Image size 2089x1764: 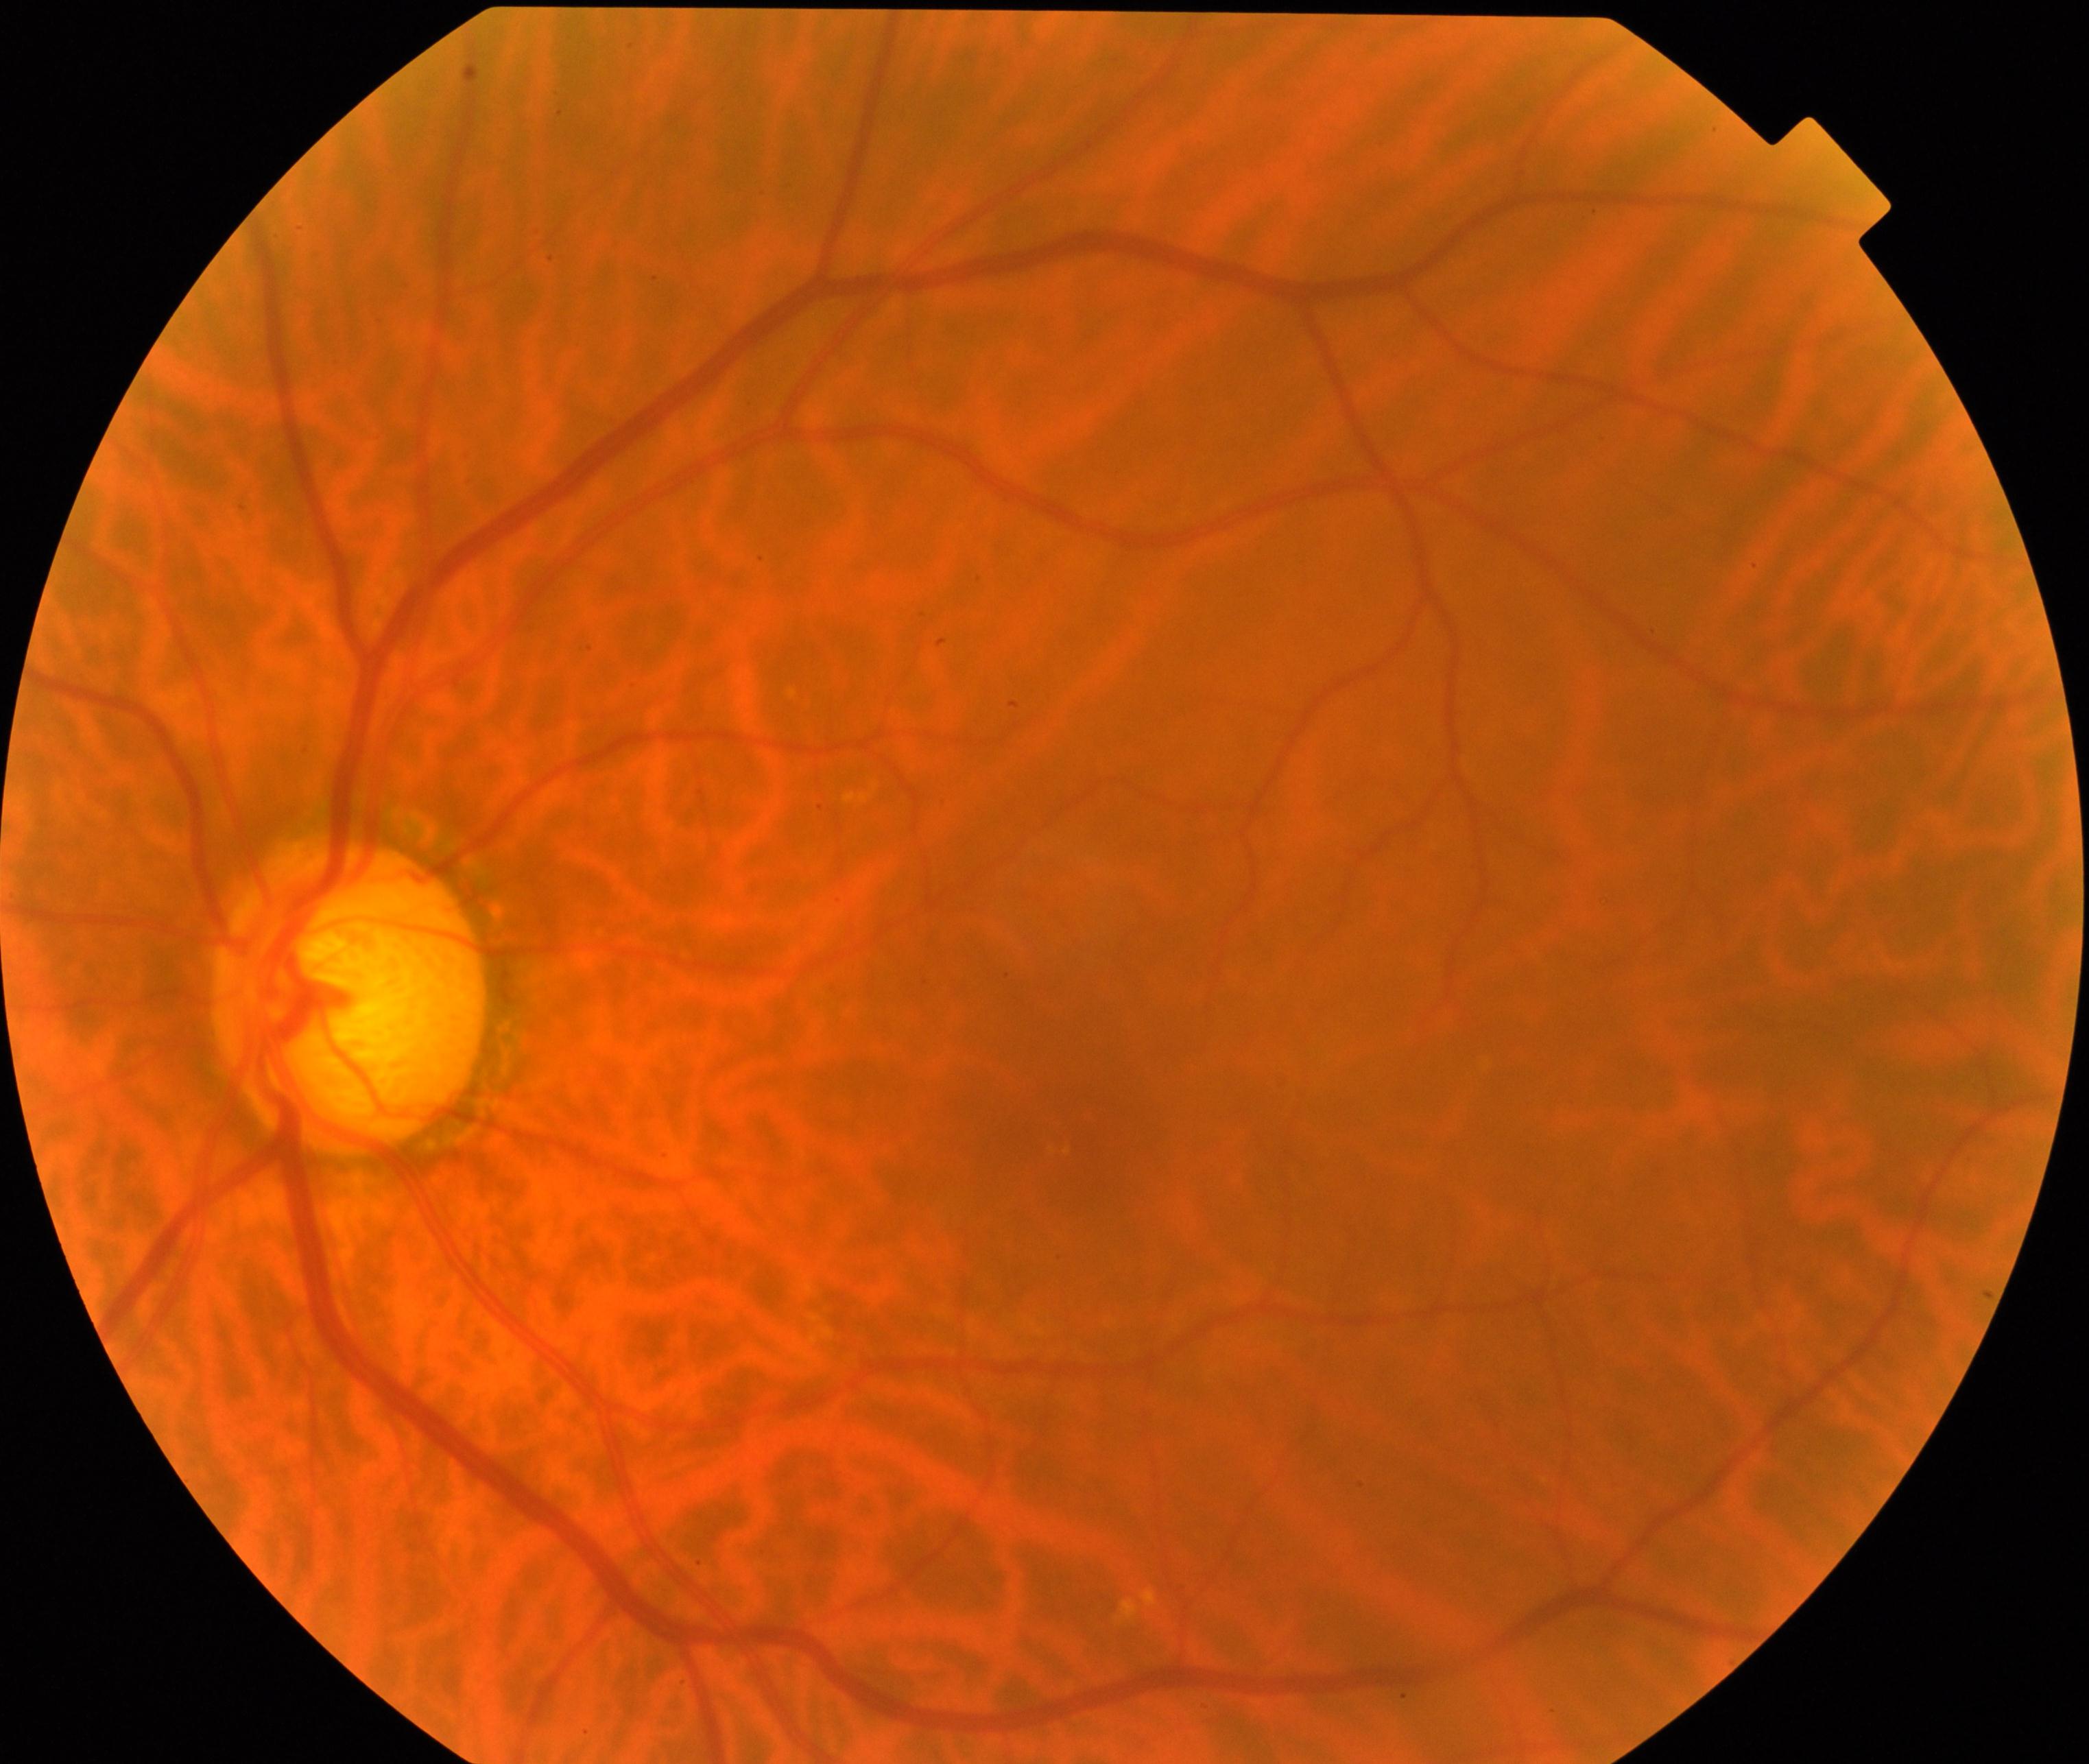
Classification: possible glaucoma.